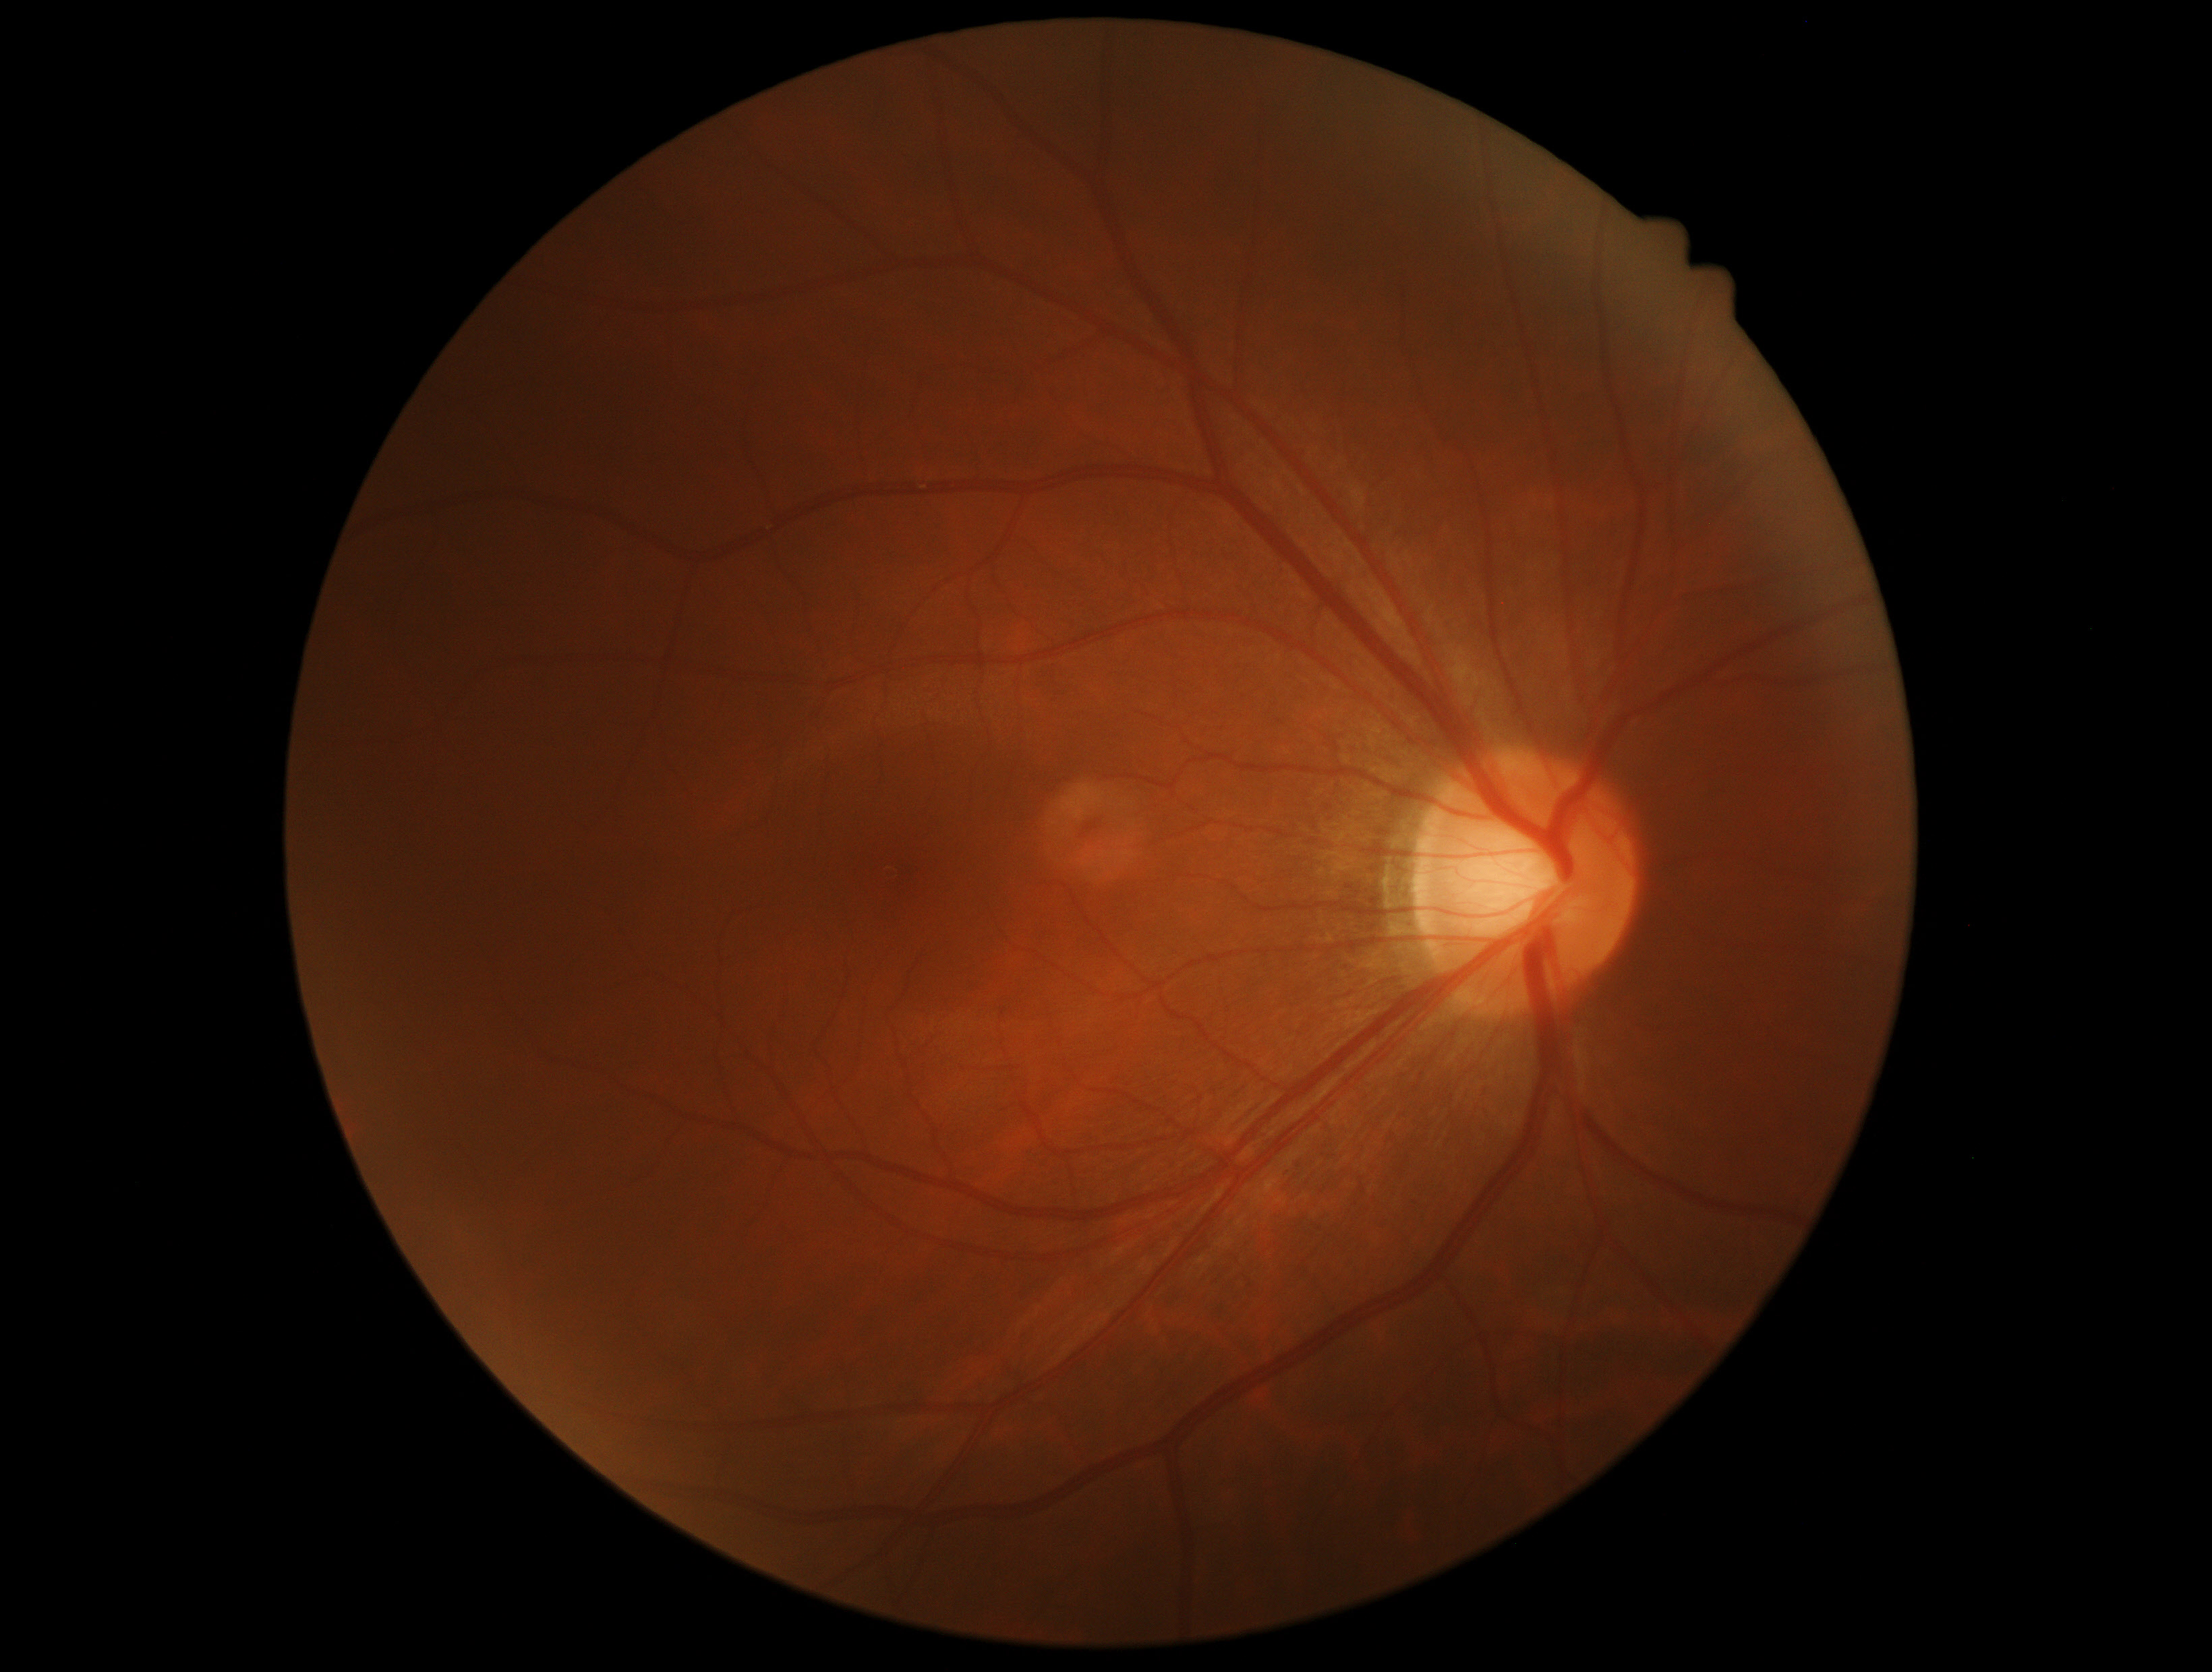 Retinopathy: 0.